45-degree field of view, fundus photo, 2184x1690 — 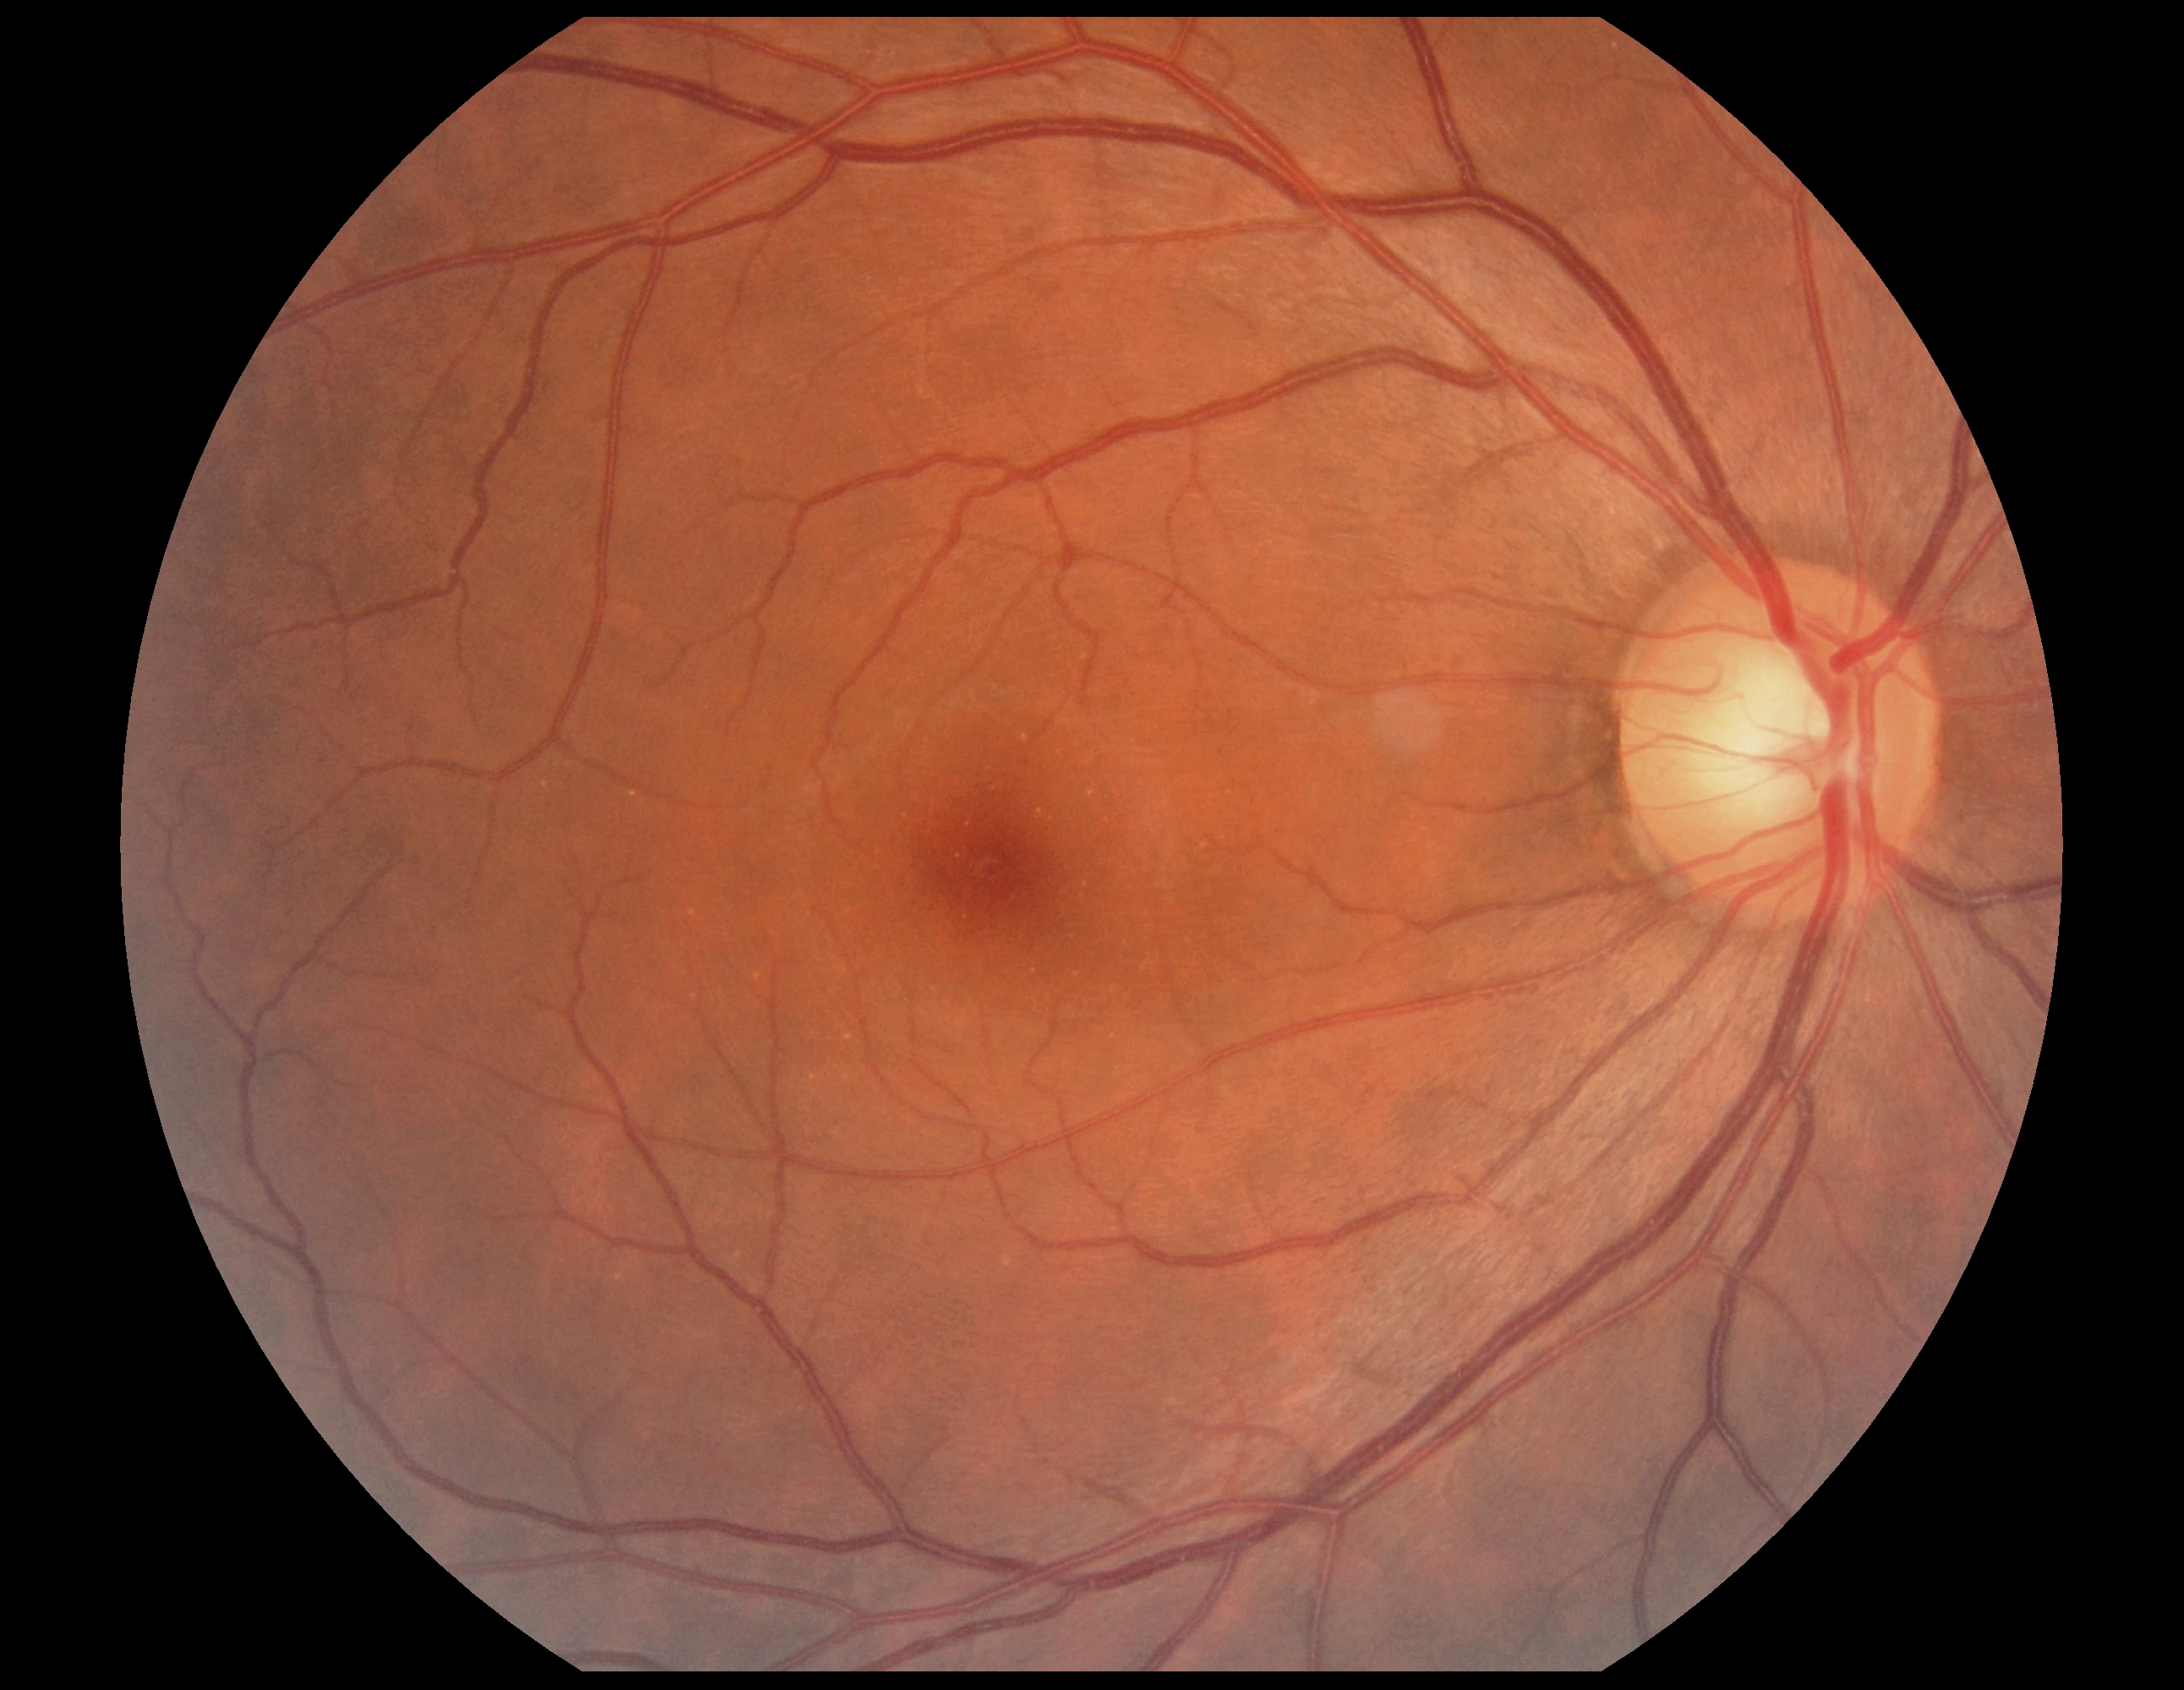

Diabetic retinopathy is grade 0 (no apparent retinopathy).
No DR findings.